Wide-field fundus photograph from neonatal ROP screening. Image size 640x480:
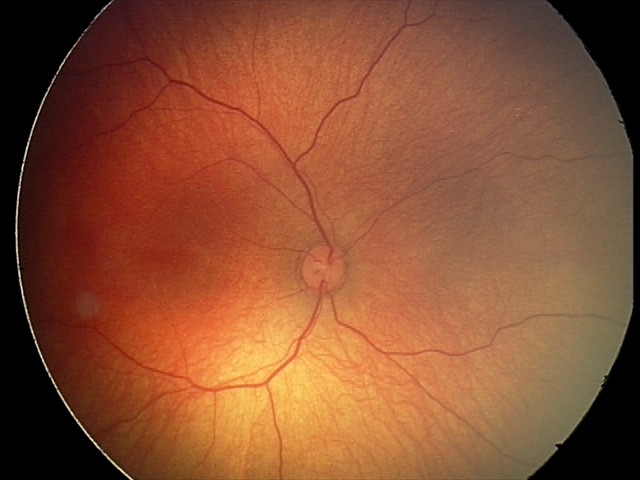
Examination with physiological retinal findings.